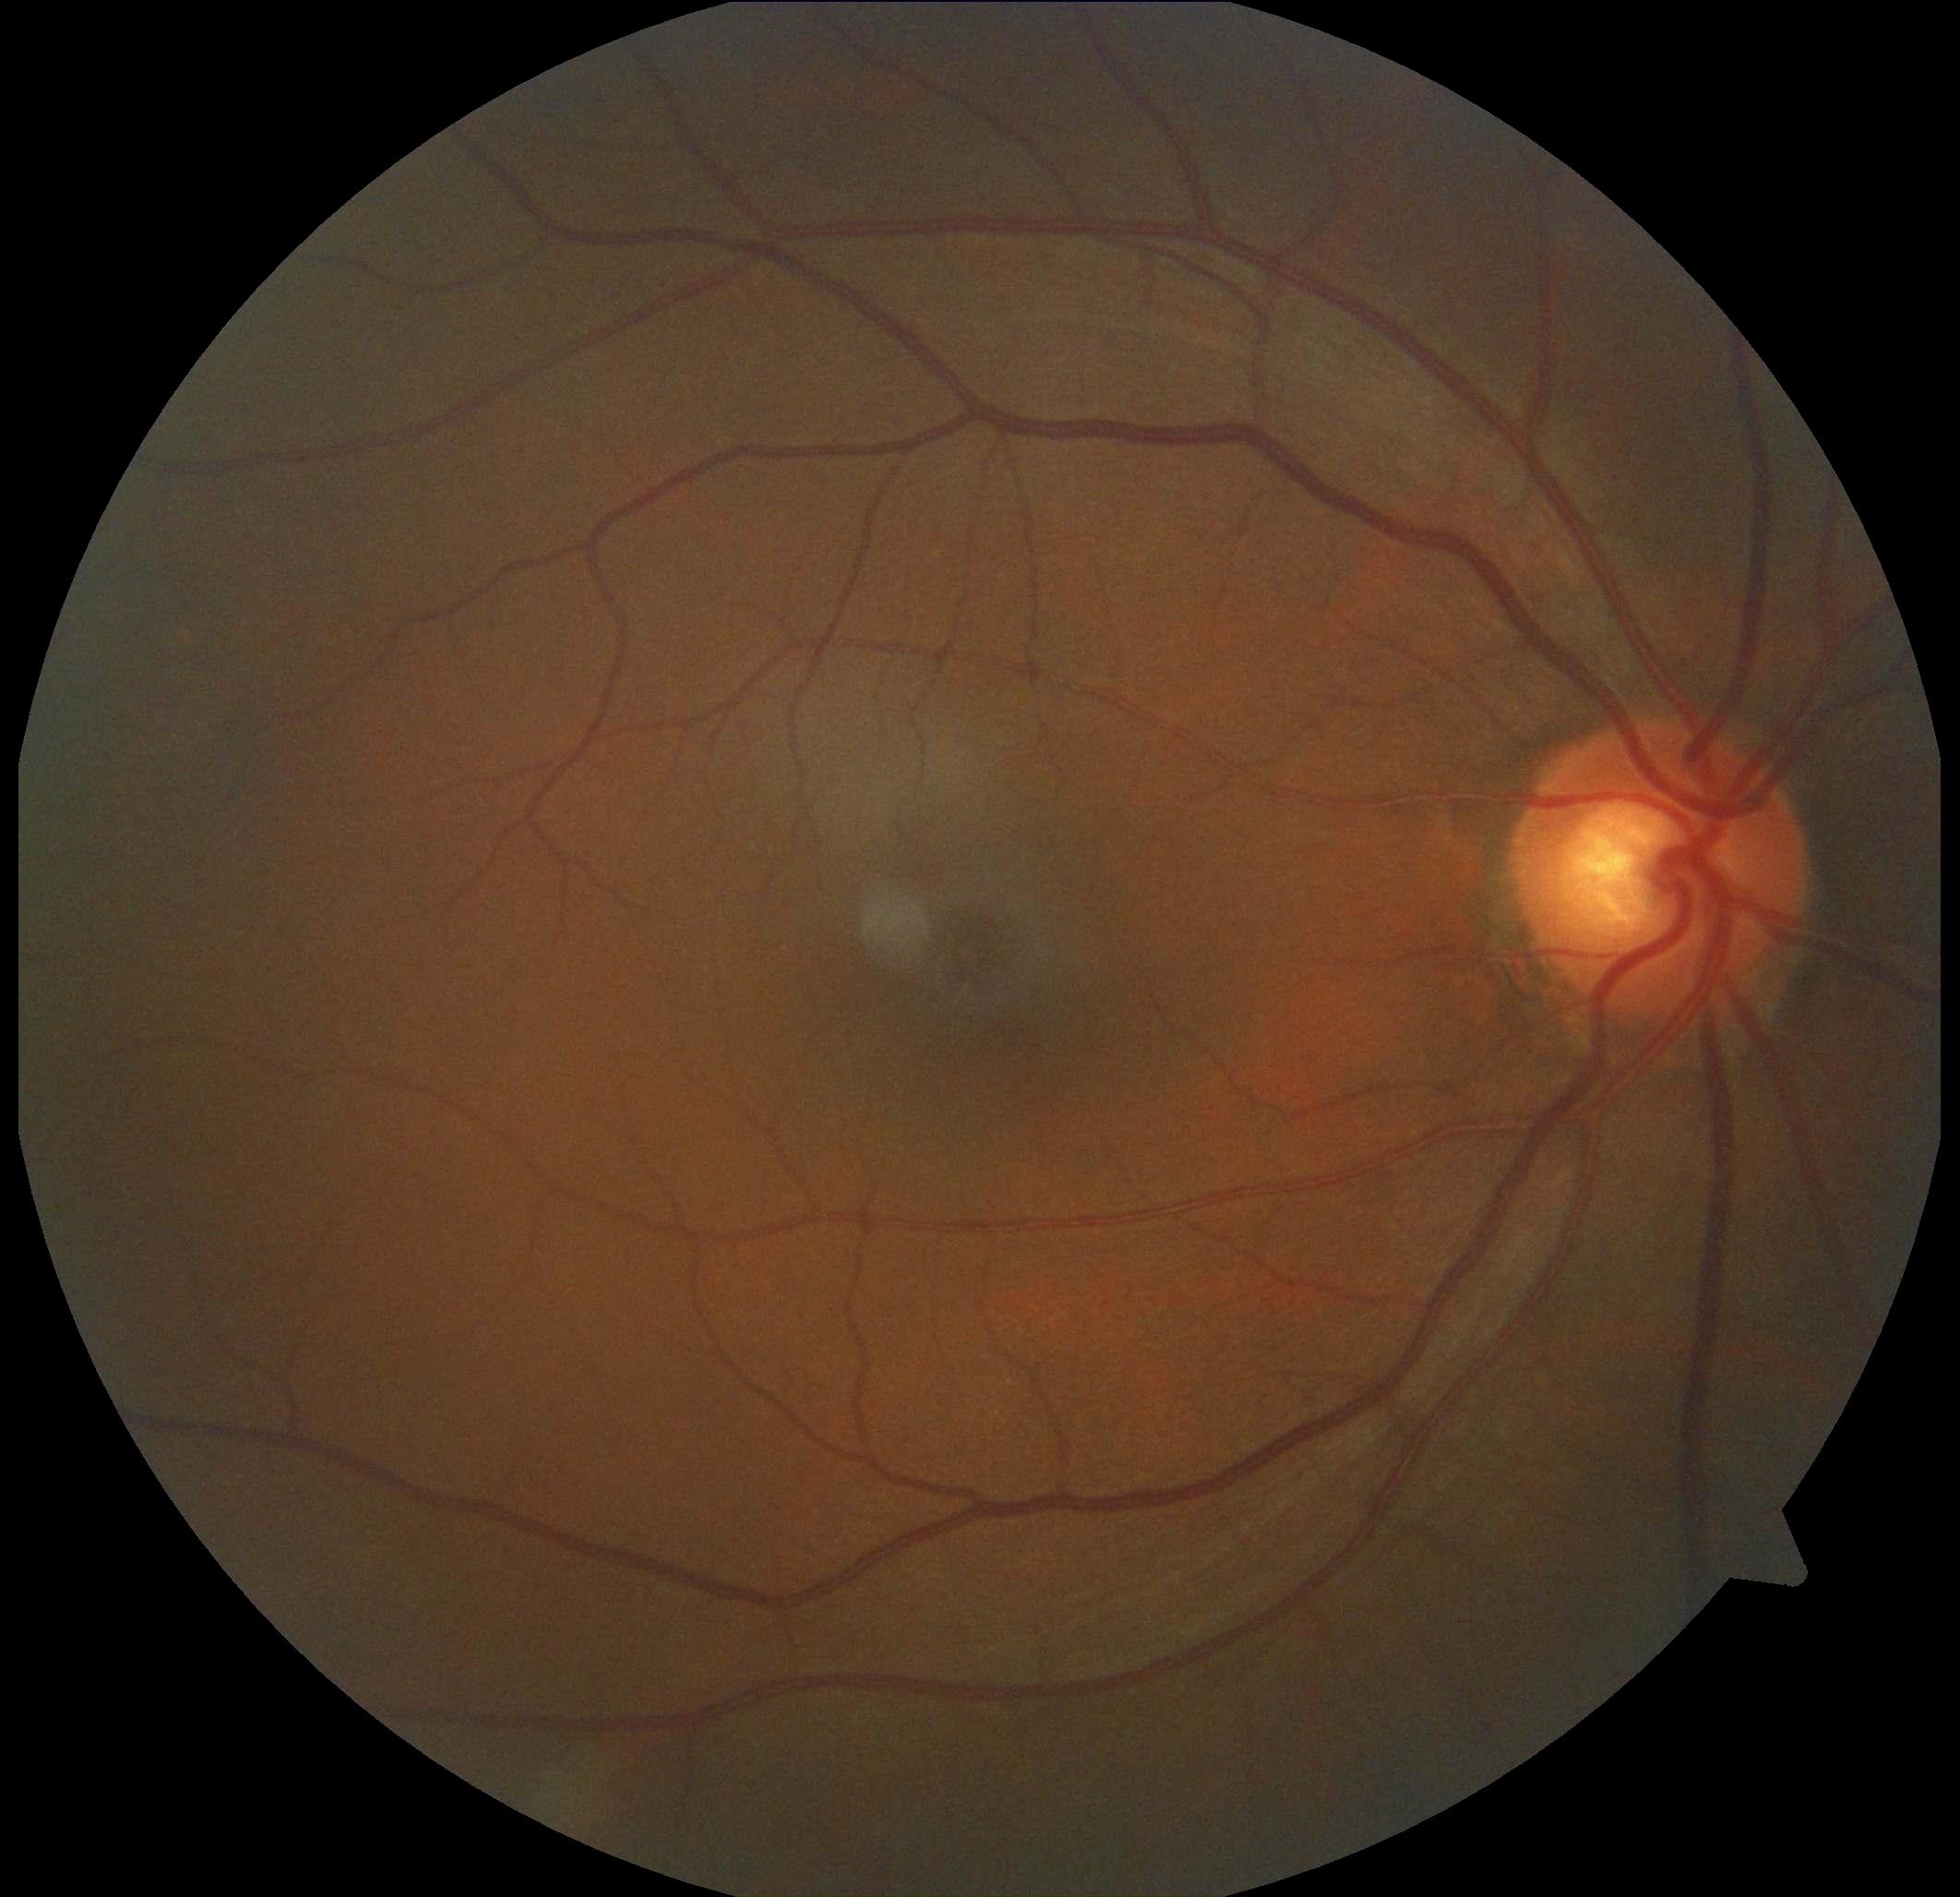

Diabetic retinopathy (DR) is no apparent diabetic retinopathy (grade 0).